2212 x 1659 pixels; retinal fundus photograph; FOV: 45 degrees
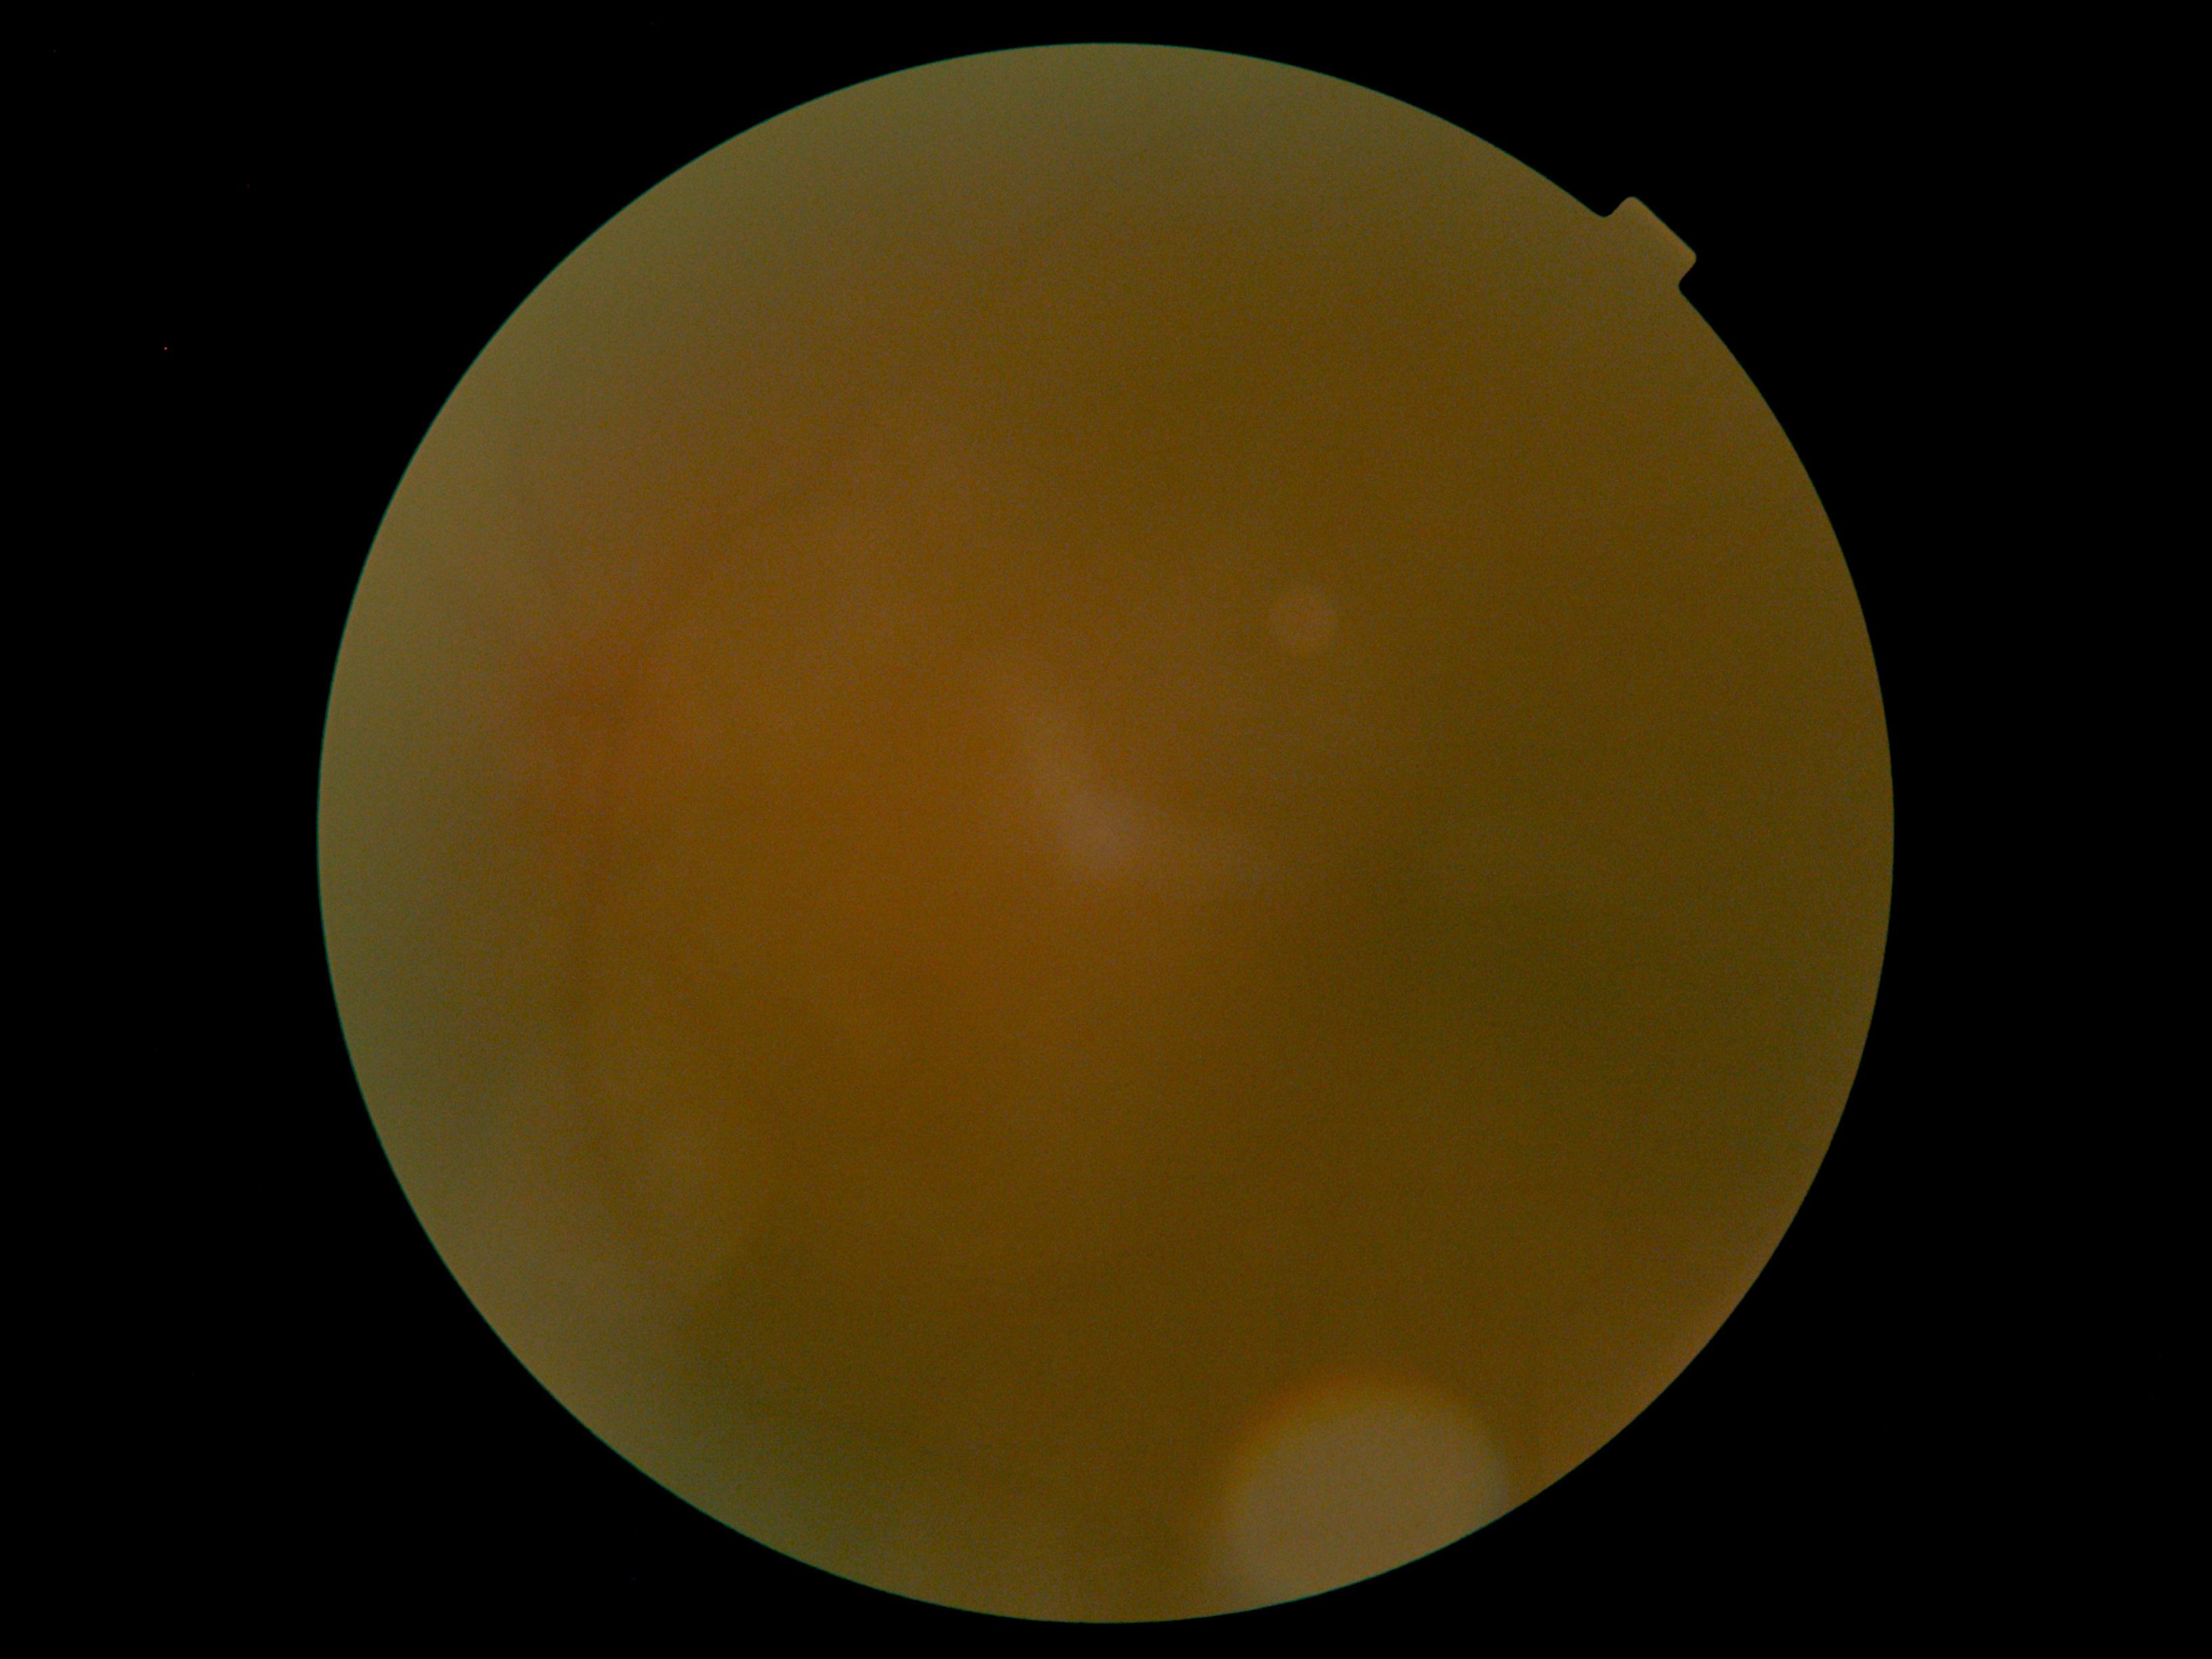
dr_grade: ungradable